922 by 922 pixels · optic nerve head photograph — 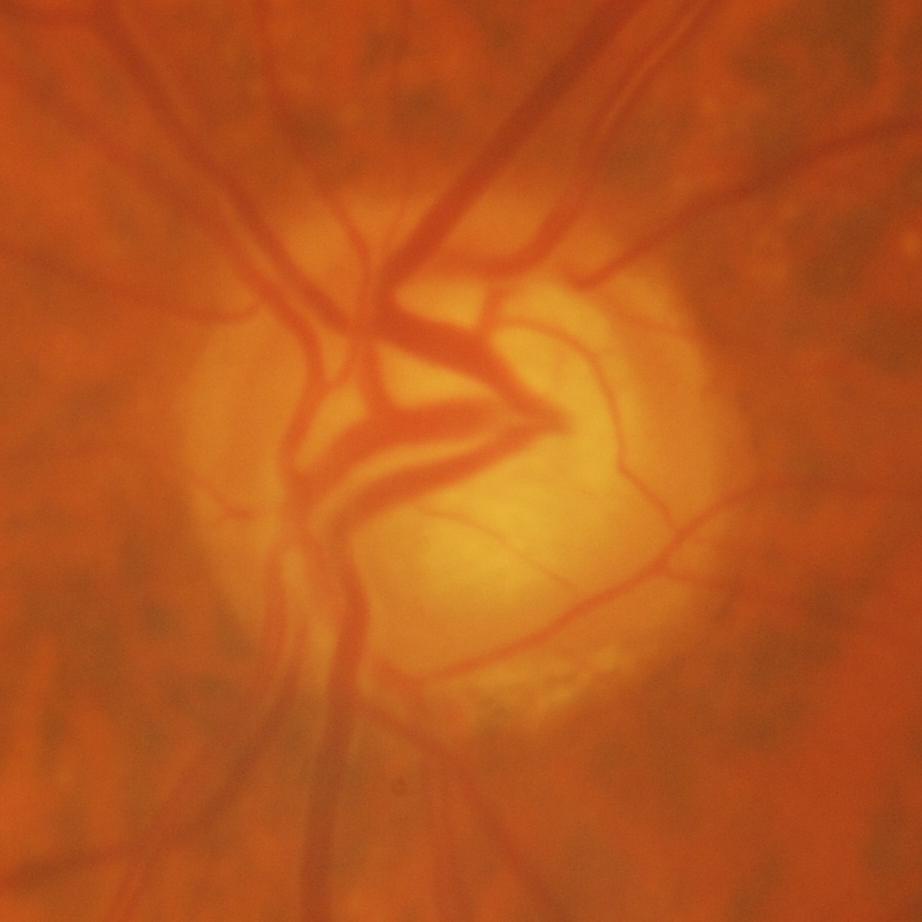
Q: What is the glaucoma diagnosis?
A: Yes — evidence of glaucoma.